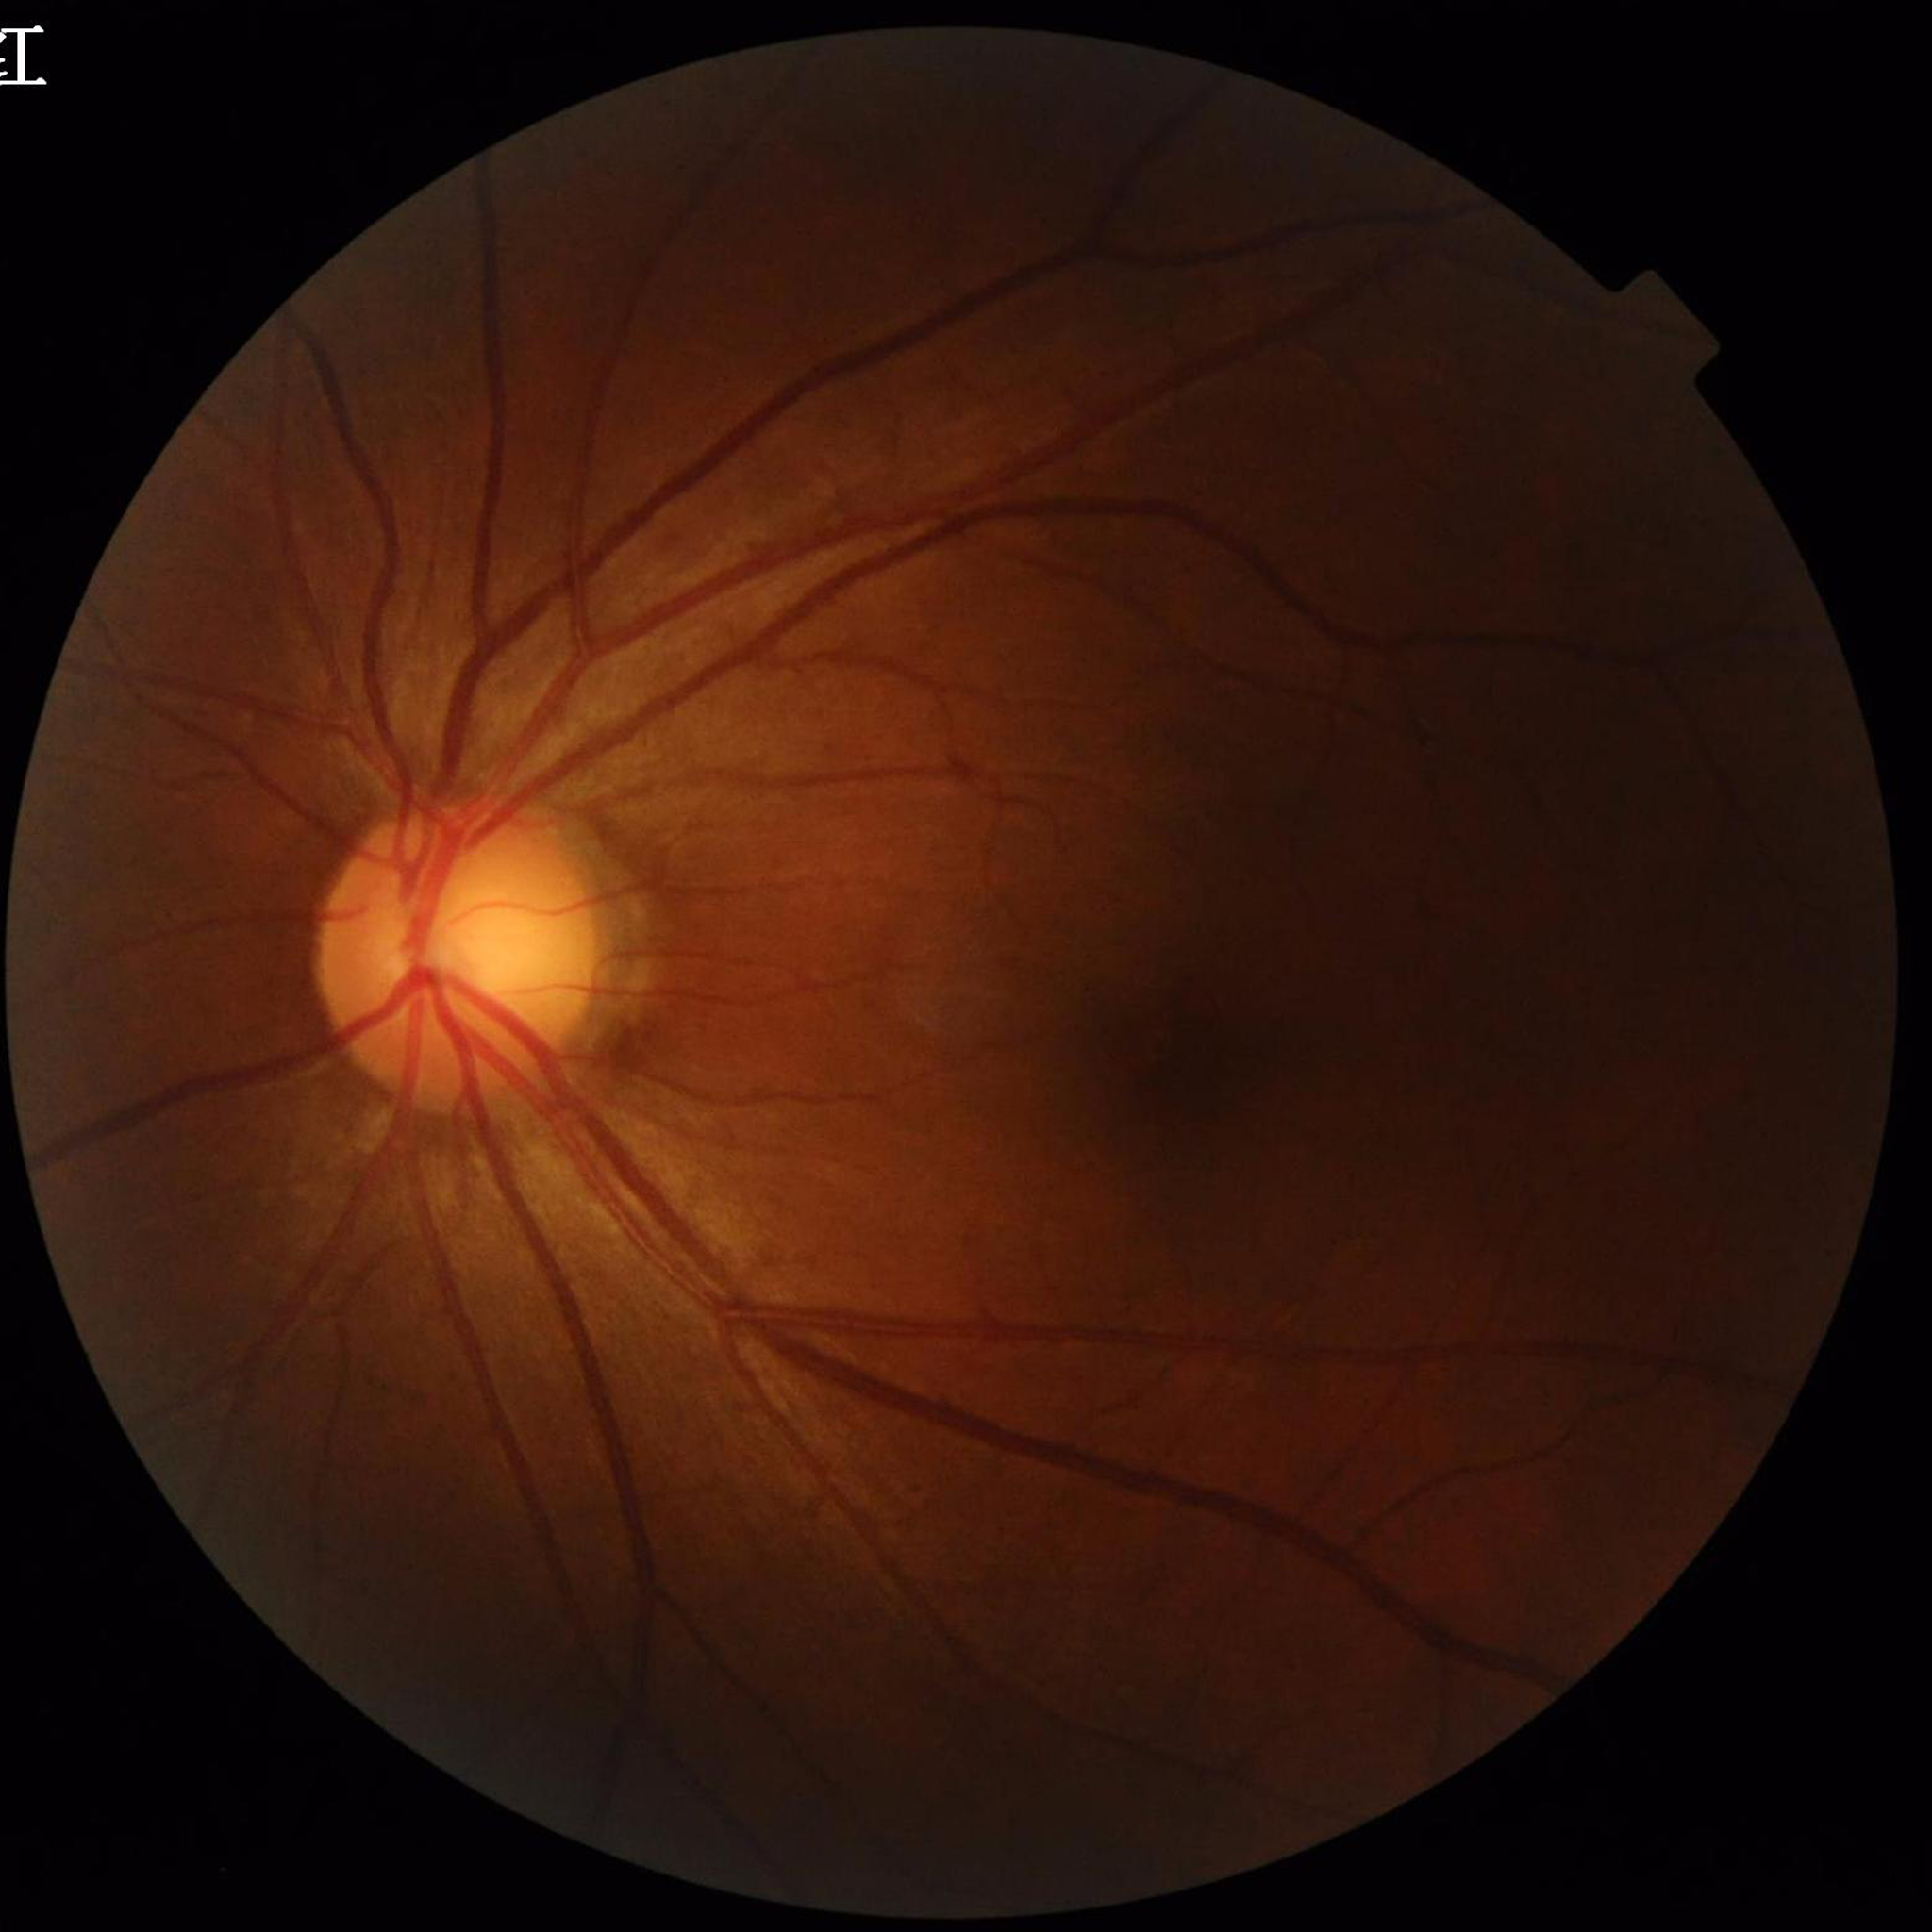 No findings of AMD, diabetic retinopathy, or glaucoma. Image quality: no blur, illumination/color distortion present, contrast adequate.